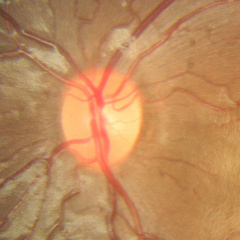
Glaucoma status = no glaucomatous changes.